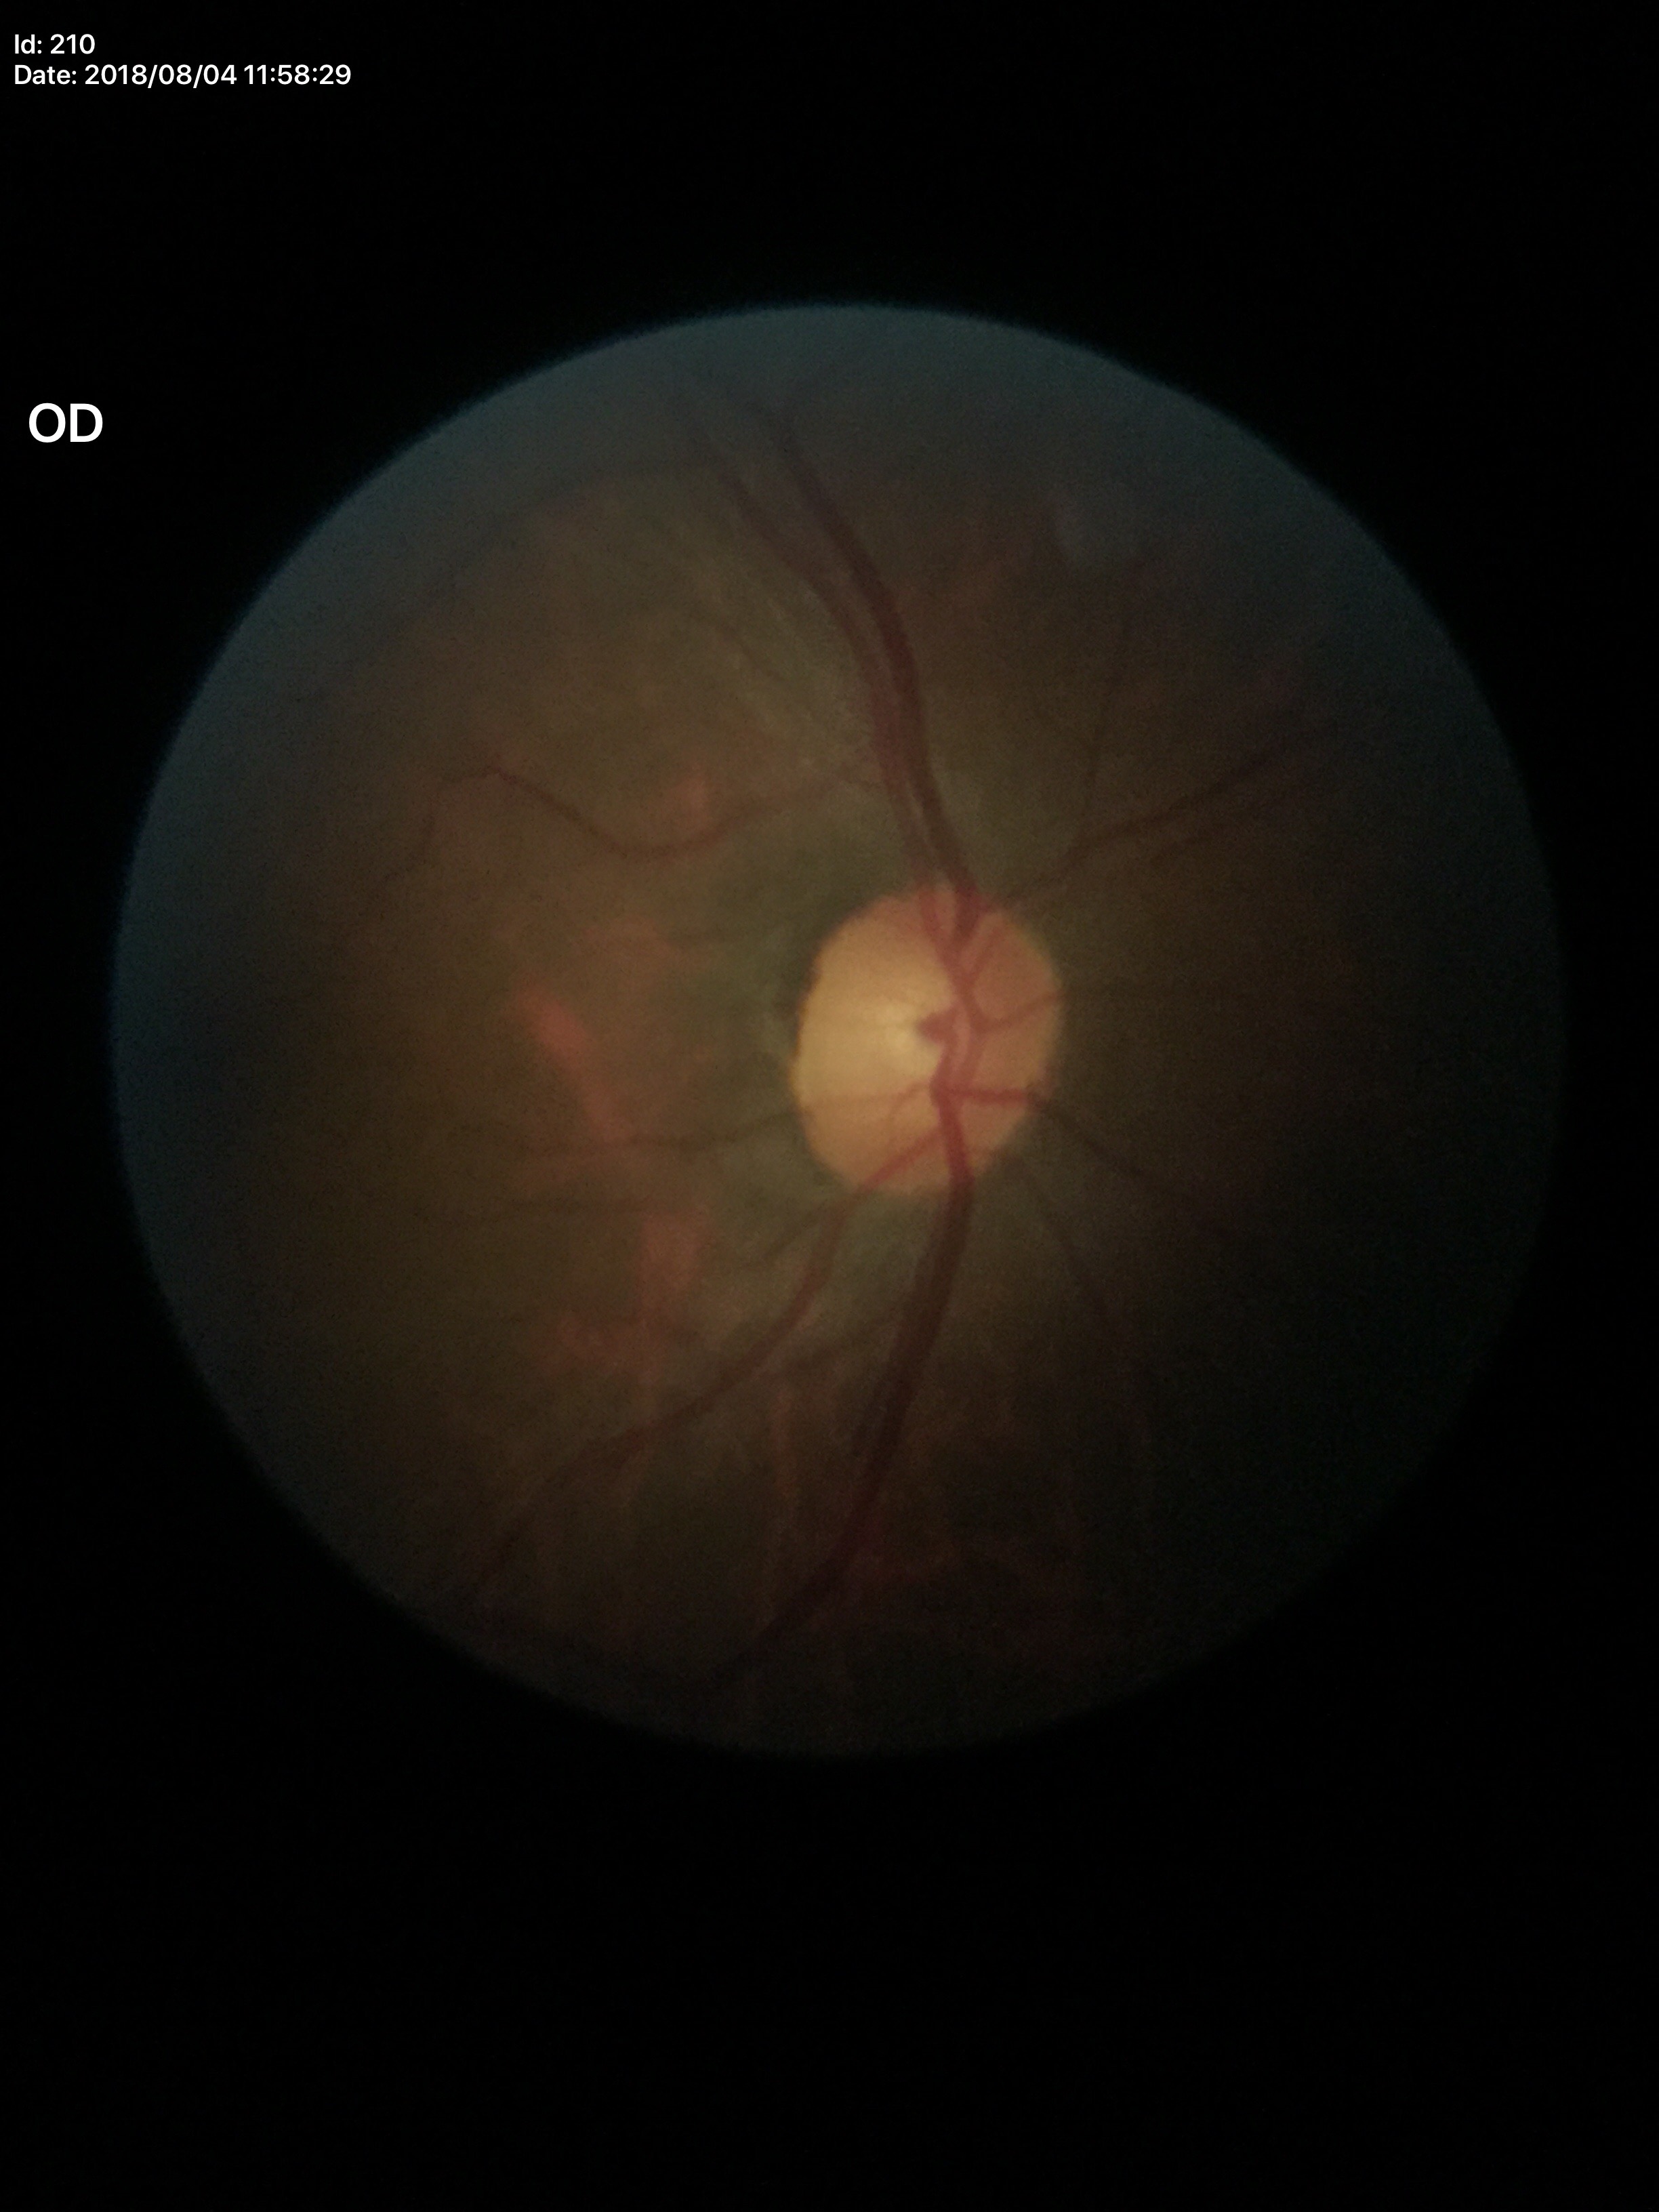 Glaucoma screening: negative.
Vertical cup-to-disc ratio (VCDR): 0.47.